2352 by 1568 pixels:
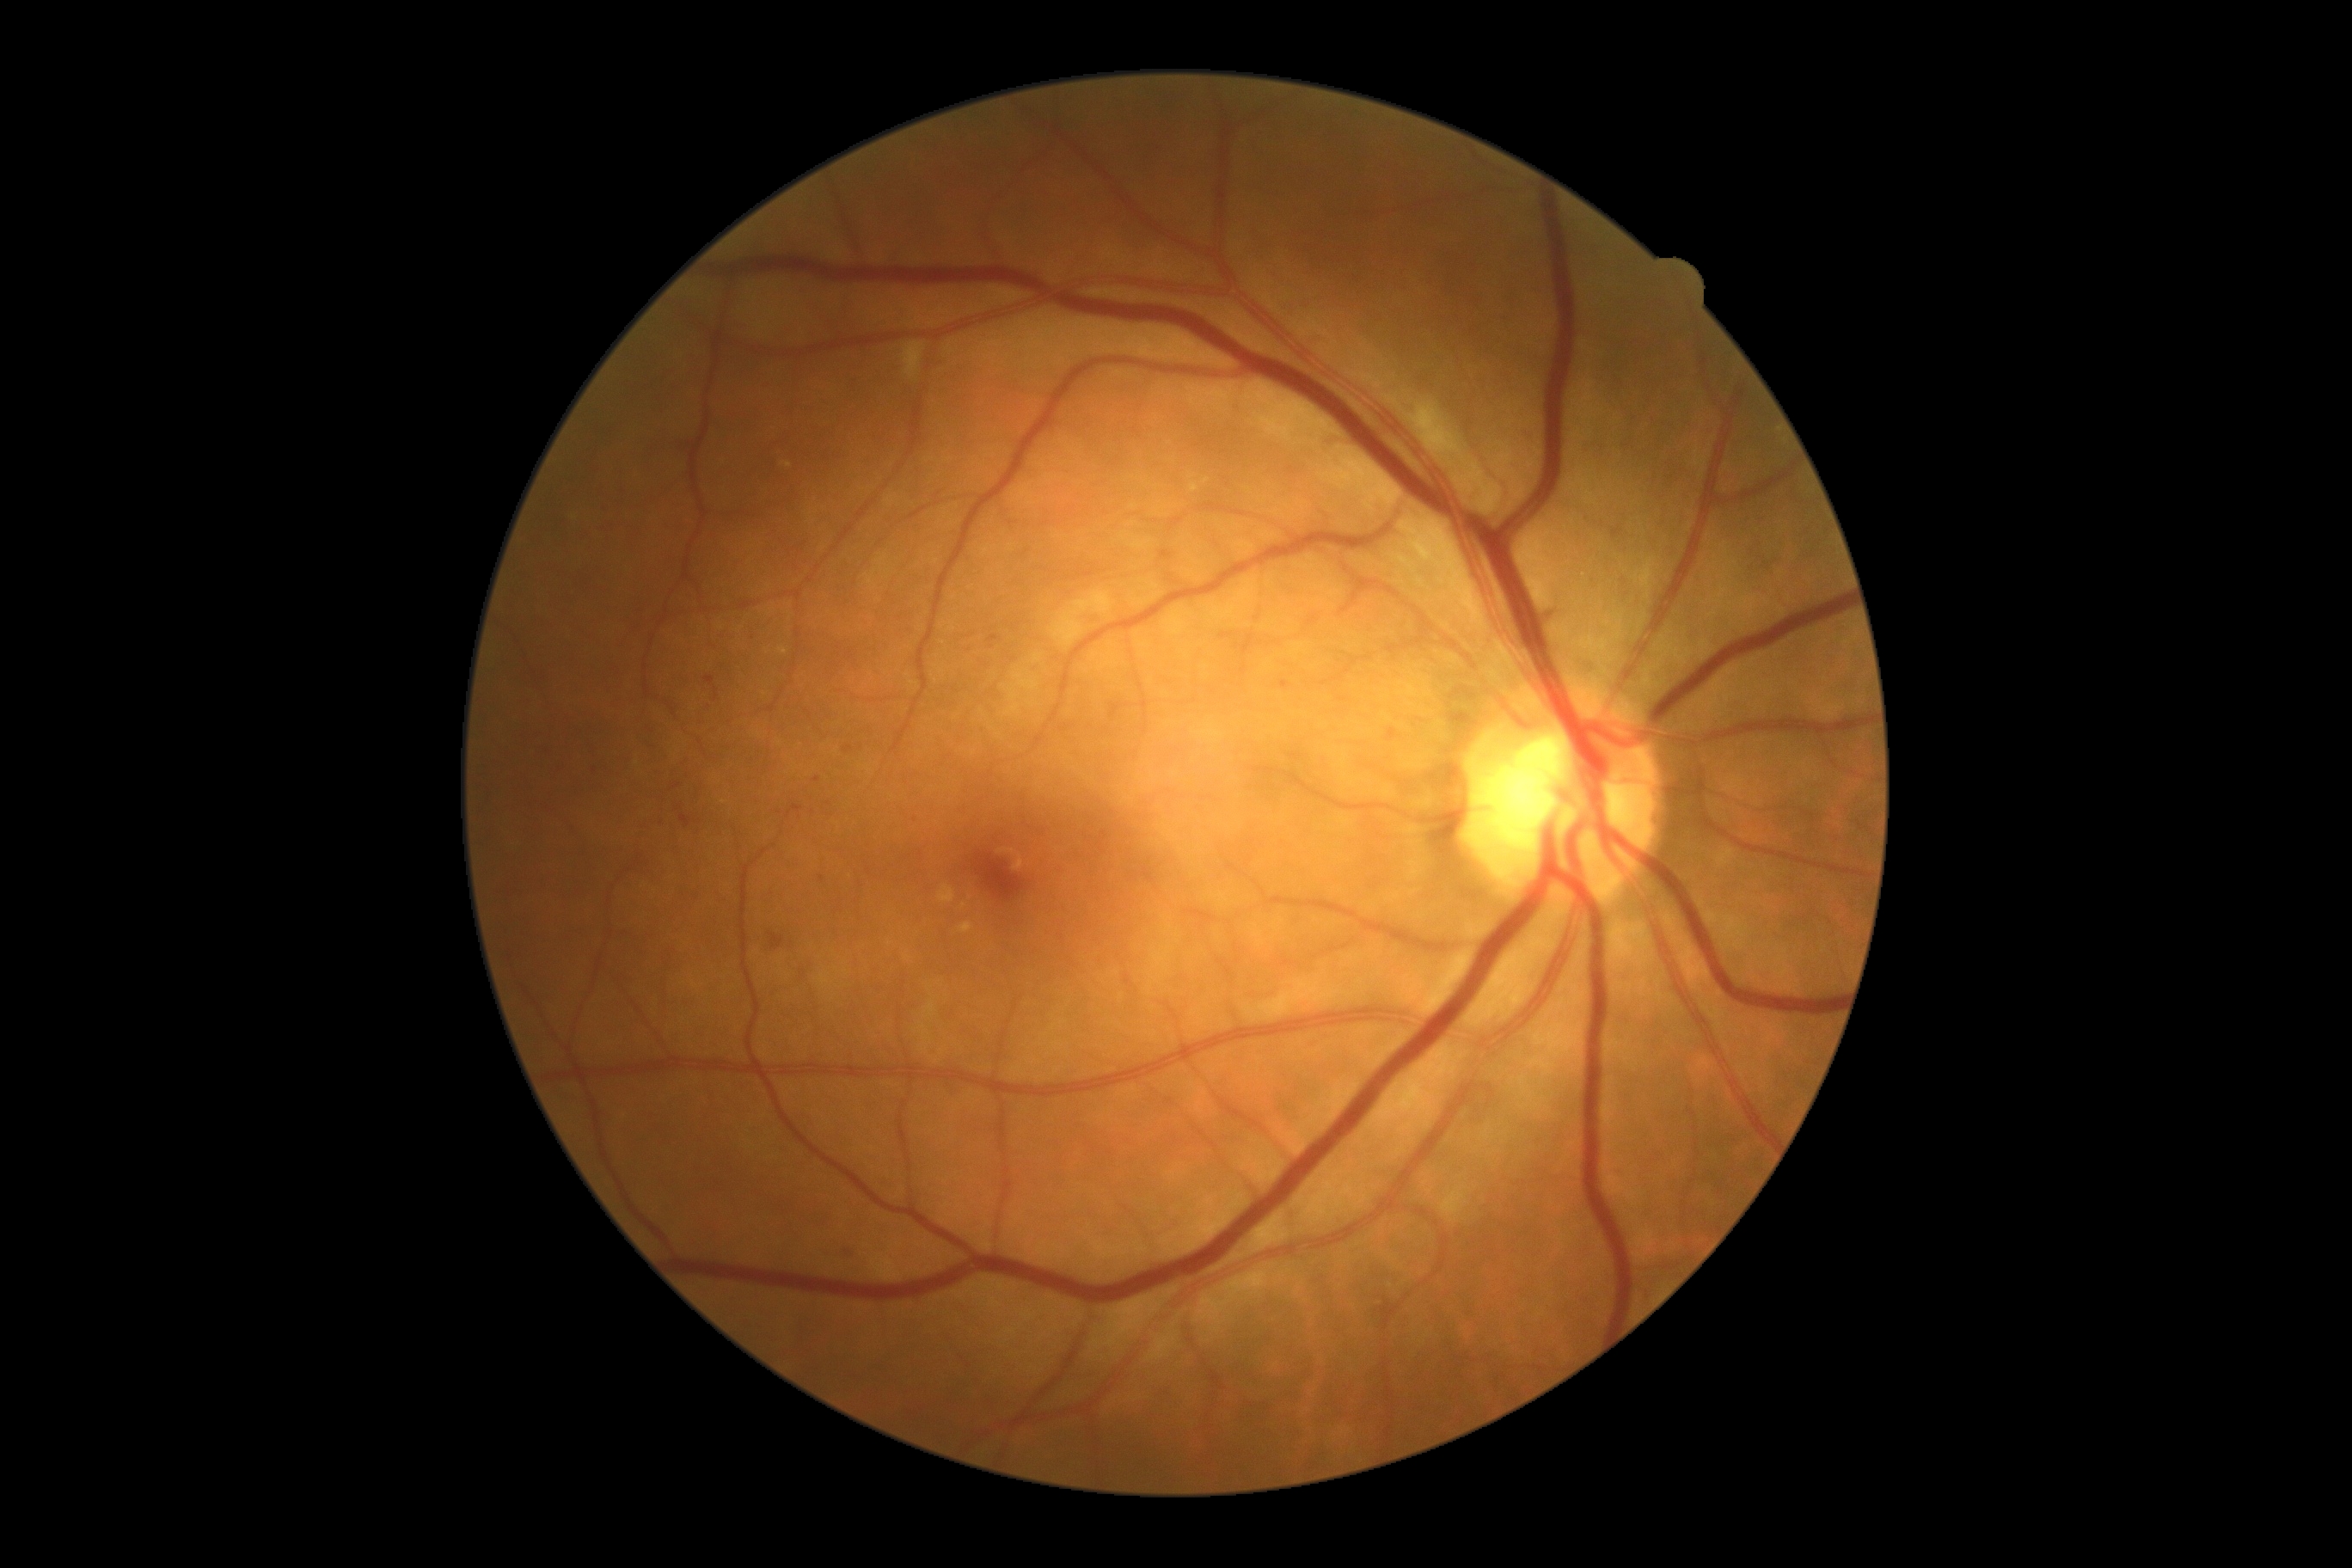 DR severity: moderate NPDR (grade 2).